Posterior pole photograph. Image size 848x848. FOV: 45 degrees. Acquired with a NIDEK AFC-230. No pharmacologic dilation:
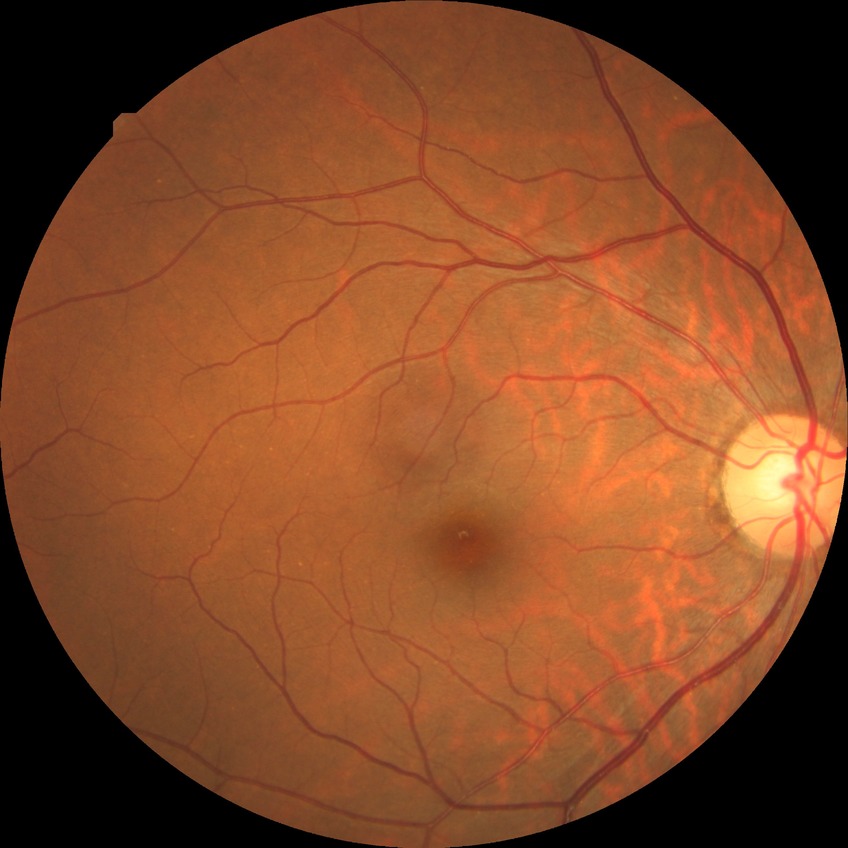 diabetic retinopathy stage@no diabetic retinopathy.